640x480. Wide-field fundus photograph from neonatal ROP screening — 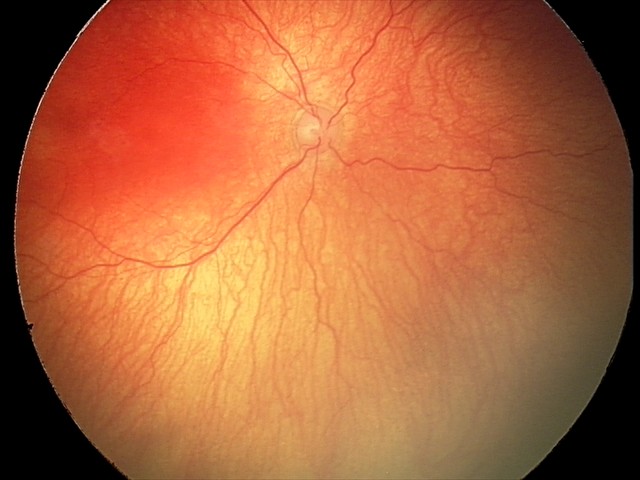 Series diagnosed as A-ROP (aggressive ROP).
With plus disease.